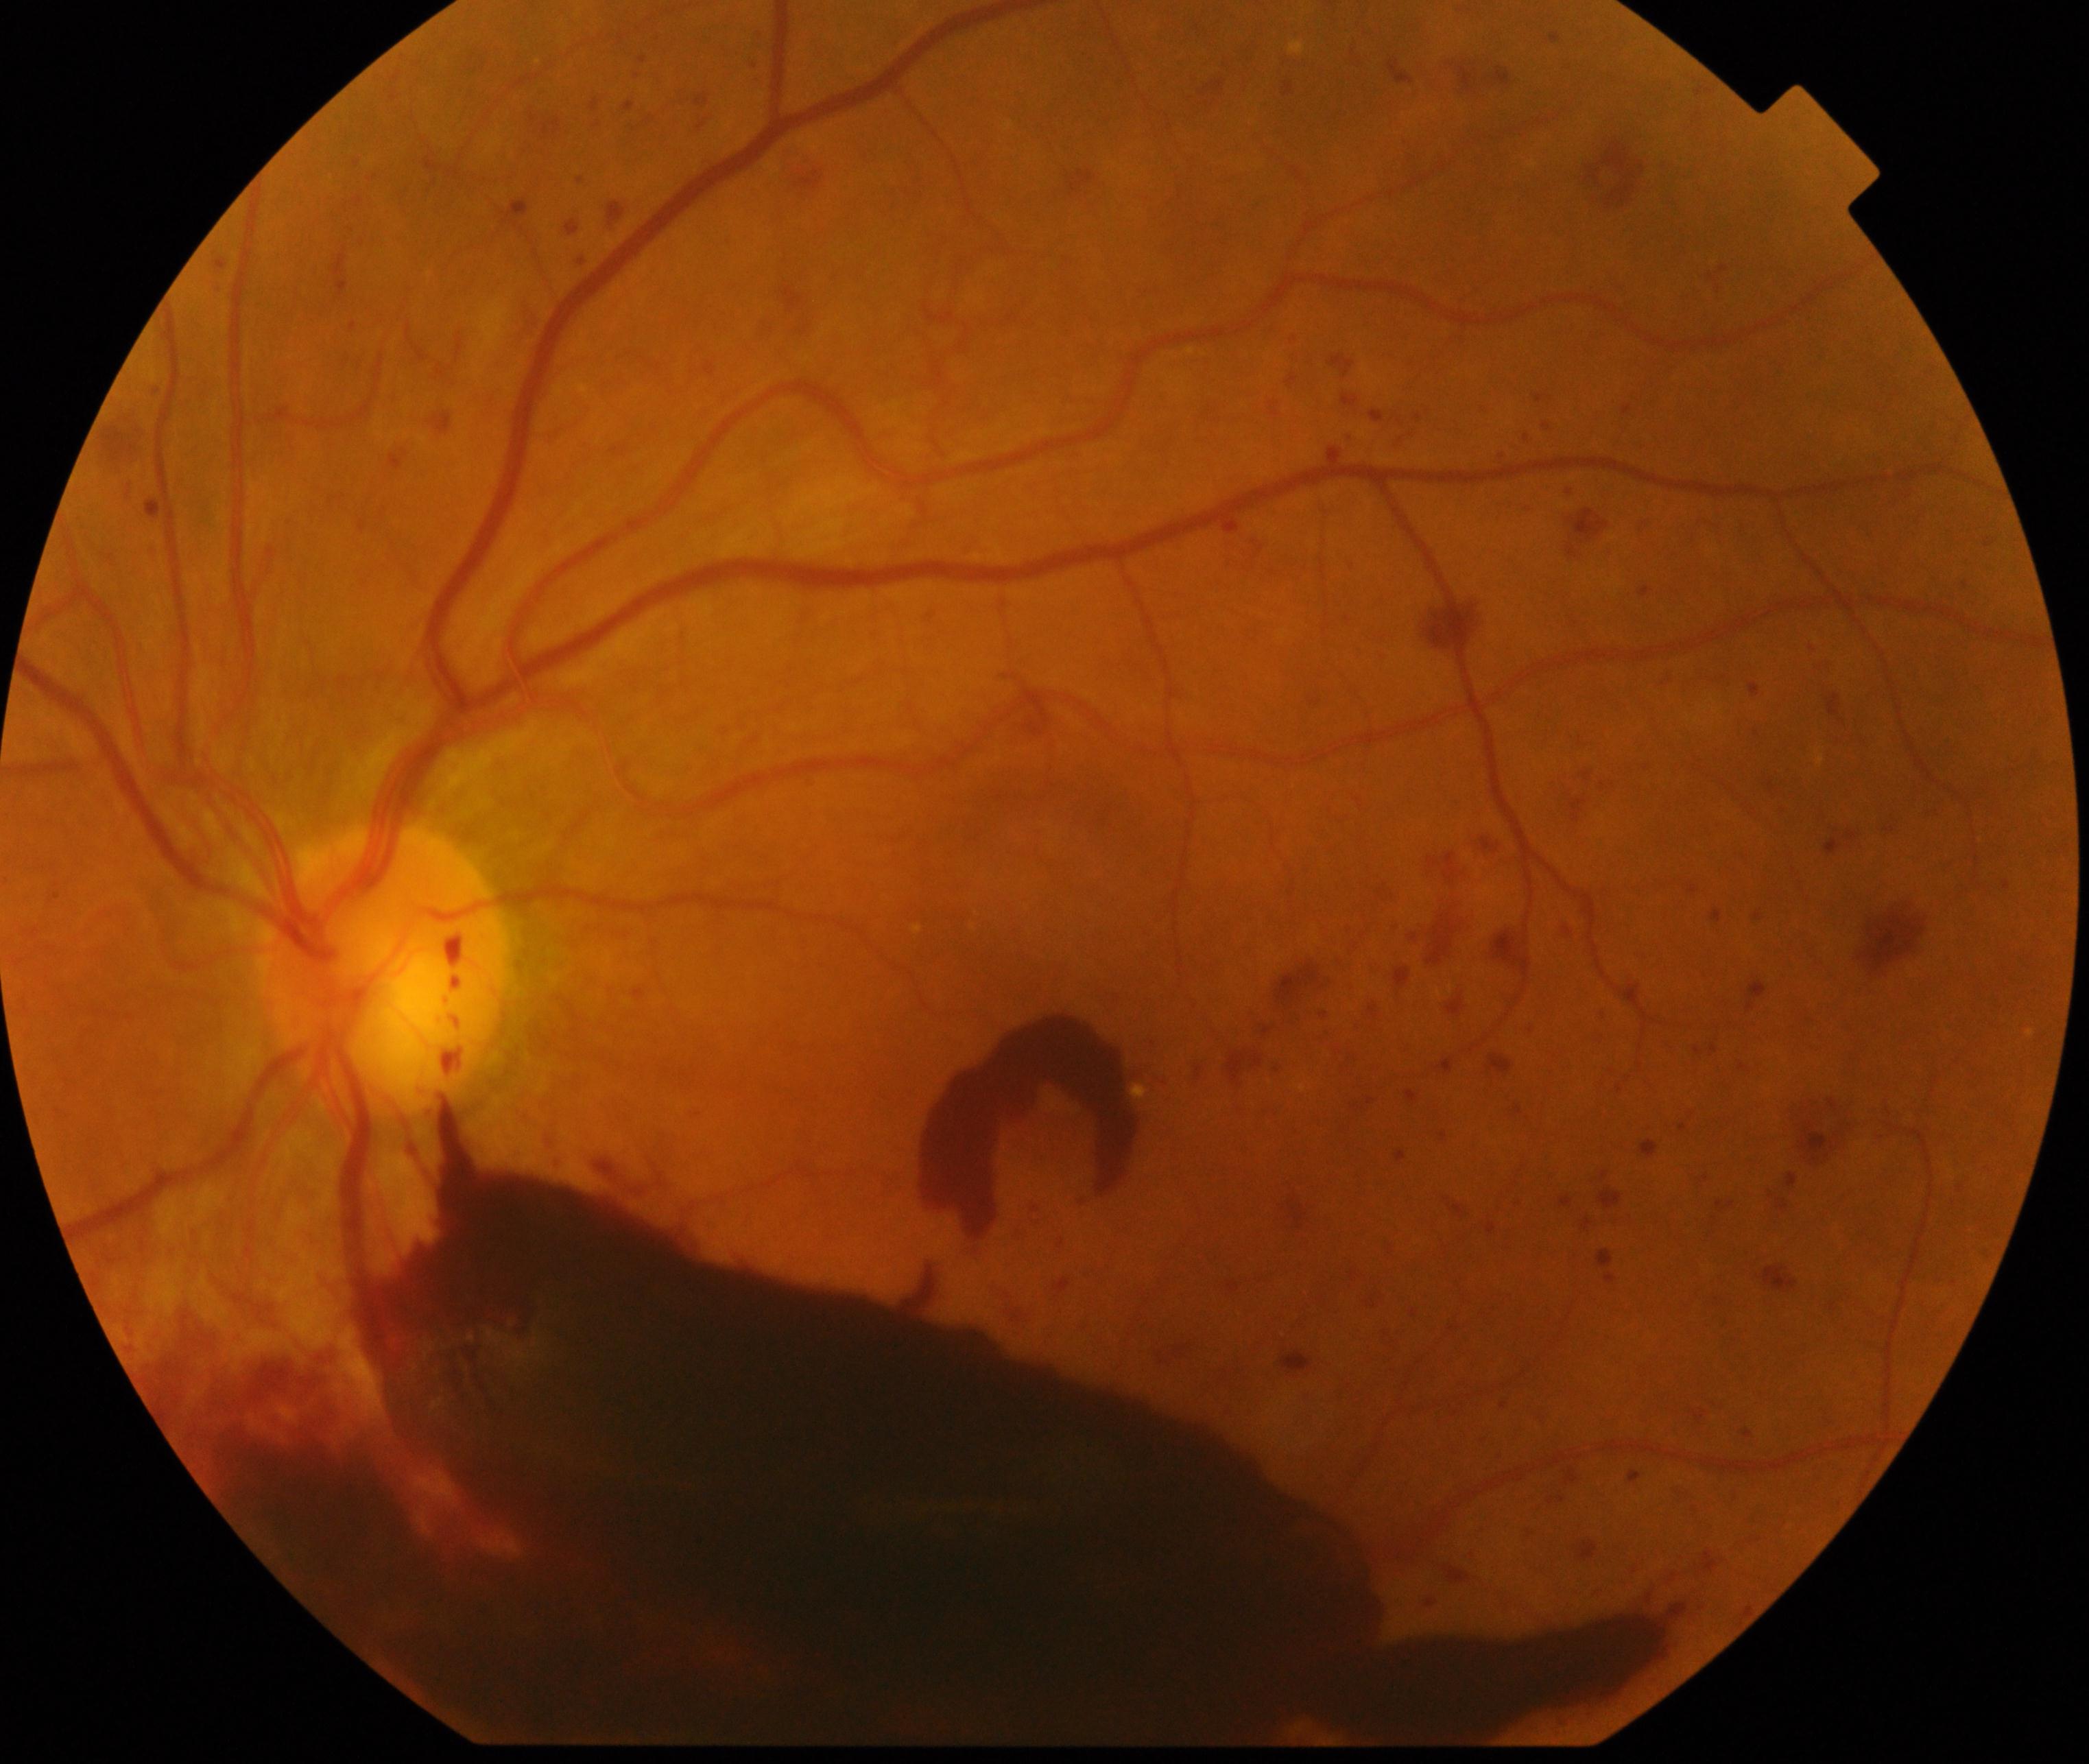

Findings: severe non-proliferative or proliferative diabetic retinopathy.